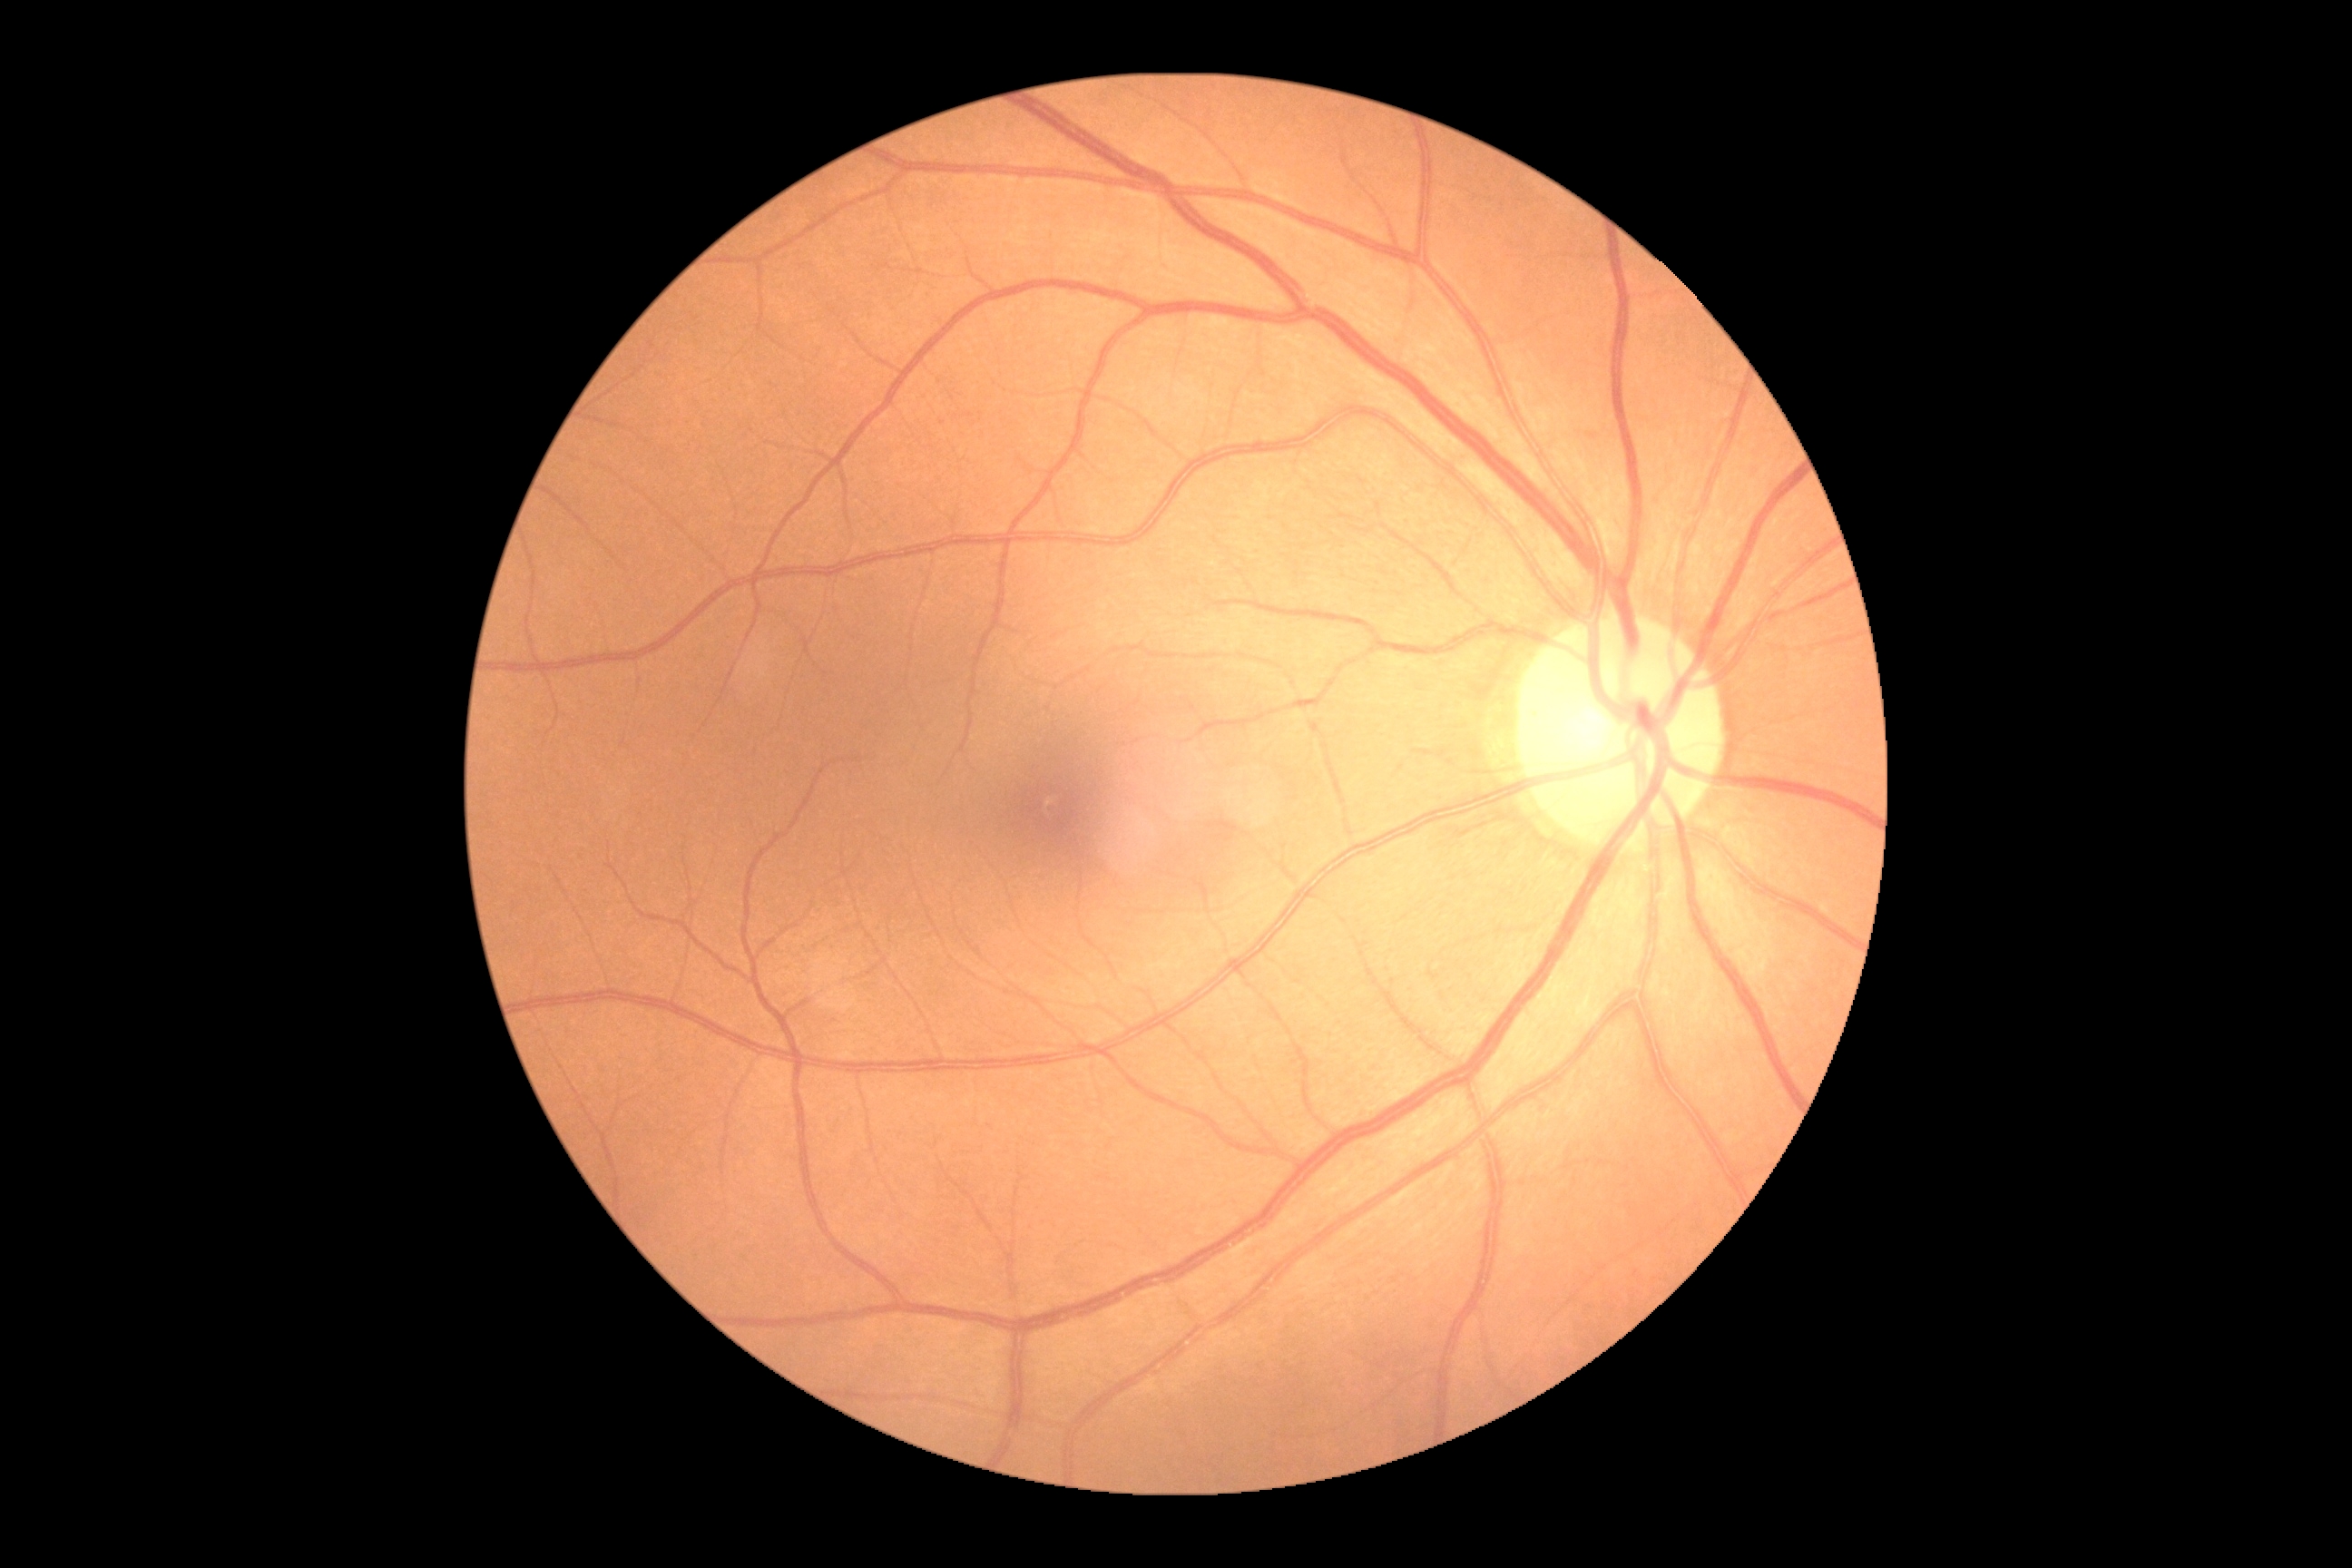 Diabetic retinopathy (DR): no apparent retinopathy (grade 0).